Modified Davis classification: 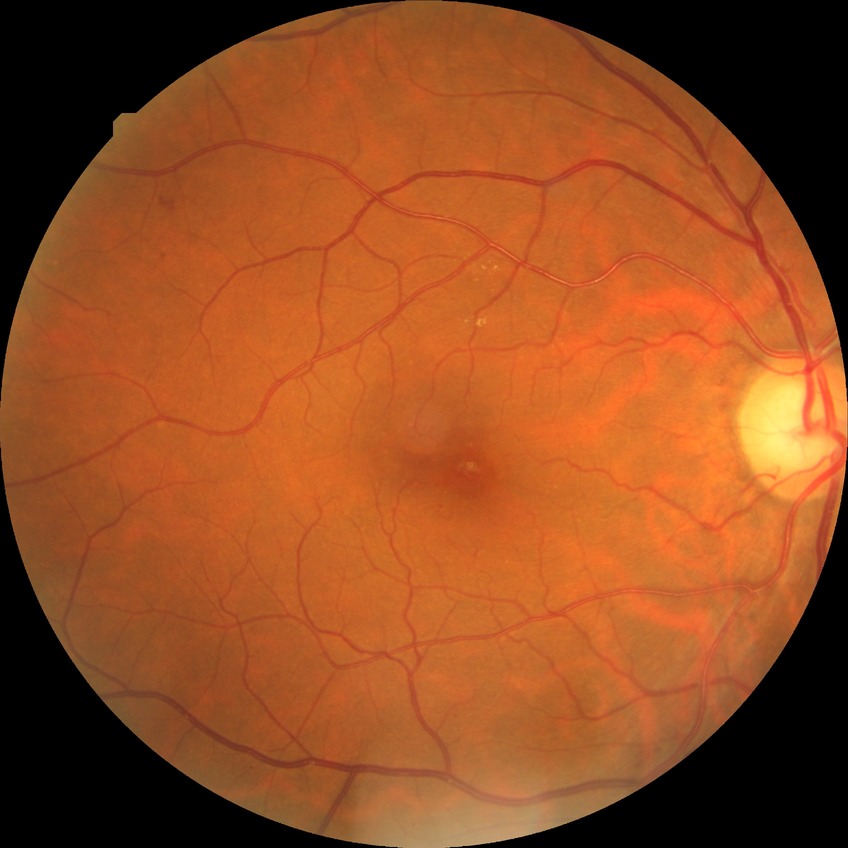 {"davis_grade": "simple diabetic retinopathy (SDR)"}